848 x 848 pixels. Camera: NIDEK AFC-230. Color fundus photograph. 45° FOV. No pharmacologic dilation: 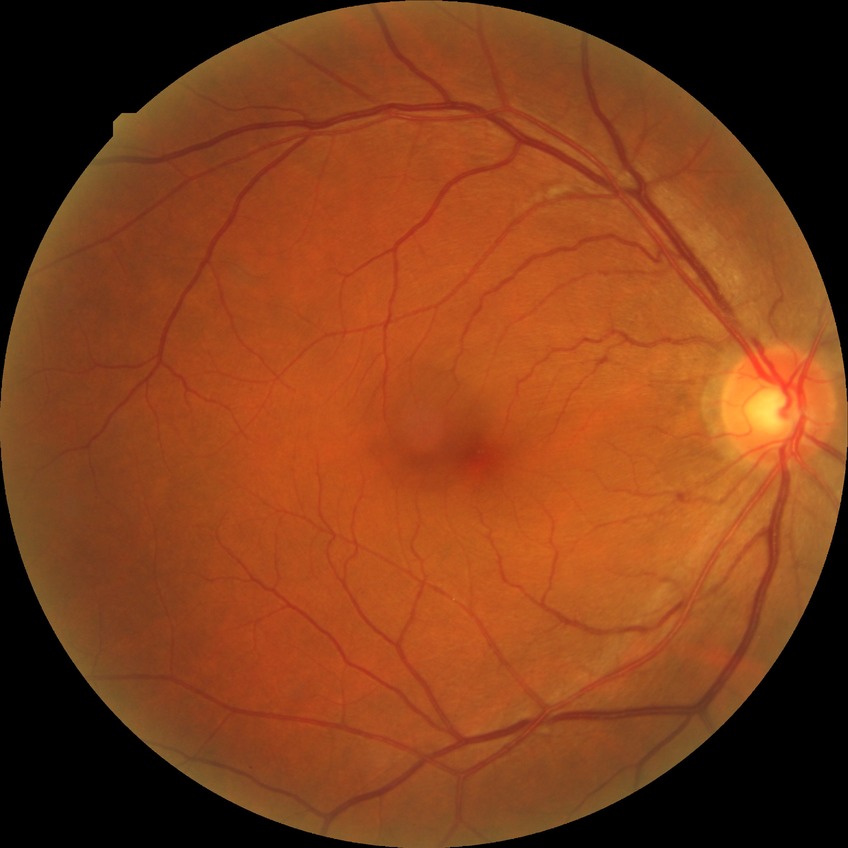

Diabetic retinopathy (DR) is simple diabetic retinopathy (SDR).